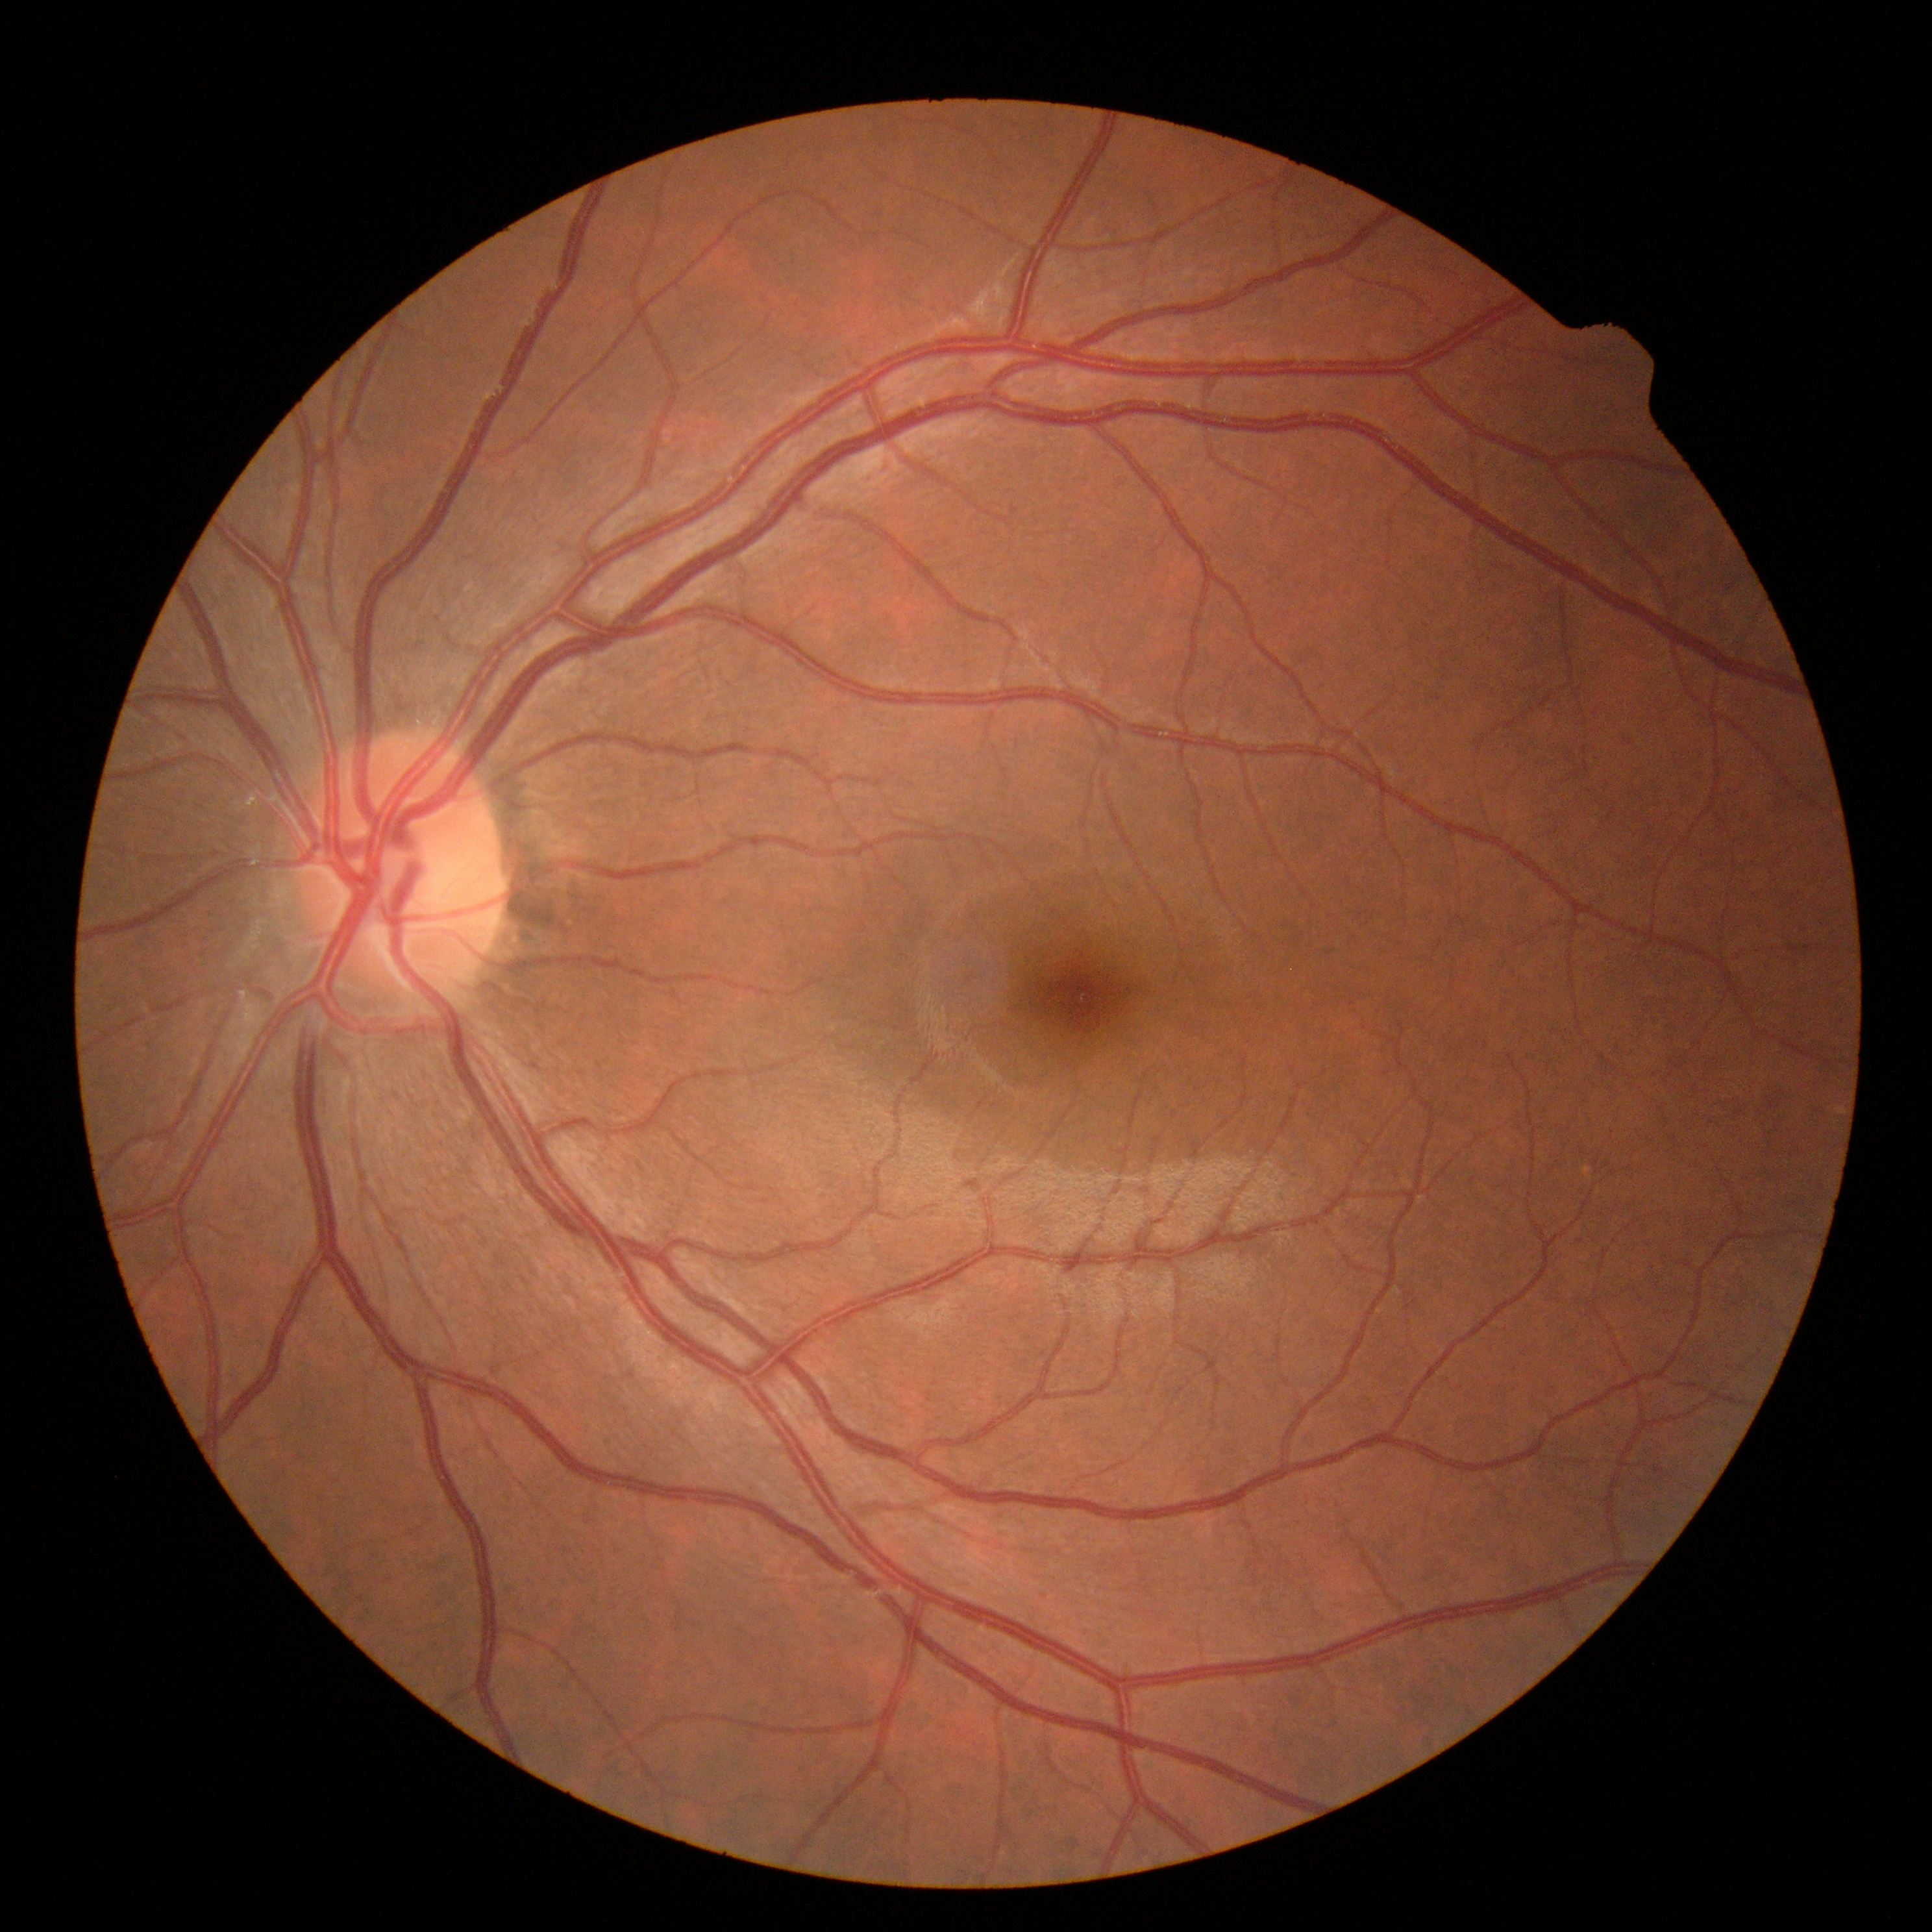
retinopathy = no apparent retinopathy (grade 0) — no visible signs of diabetic retinopathy; DR impression = negative for DR.